Fundus photo
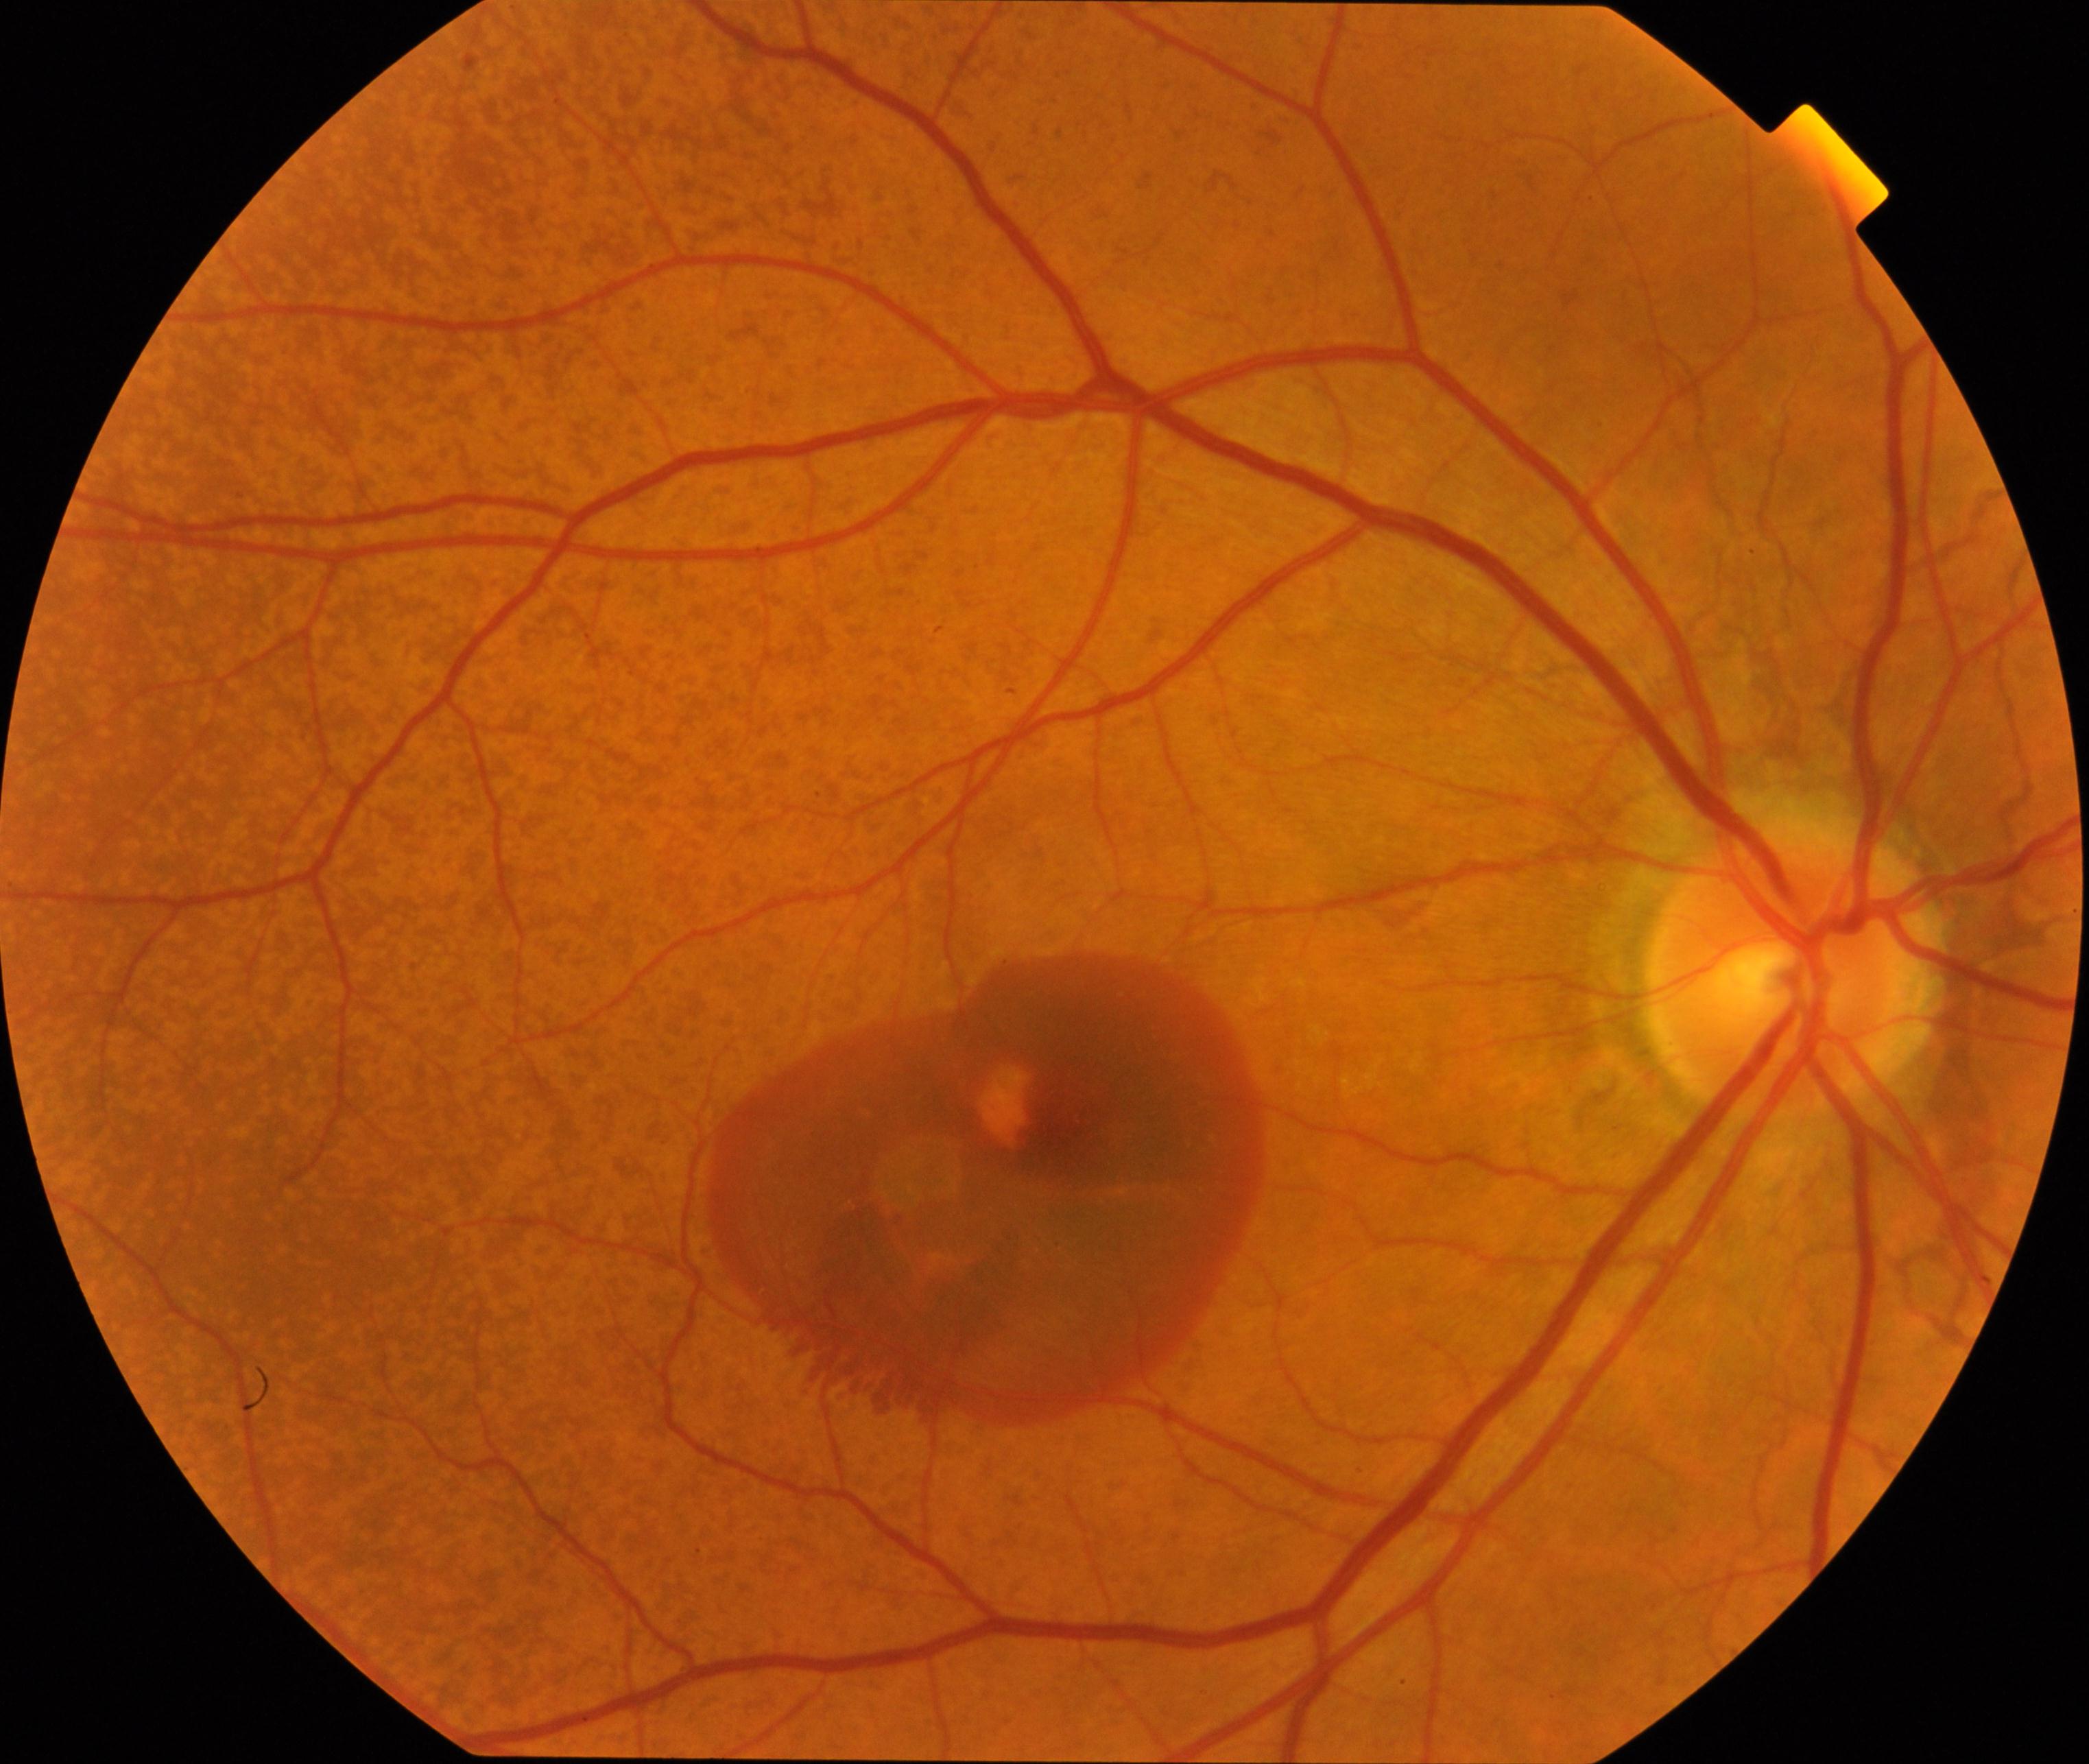 Diagnosis: maculopathy.